Undilated pupil. Topcon TRC-NW400. Color fundus photograph:
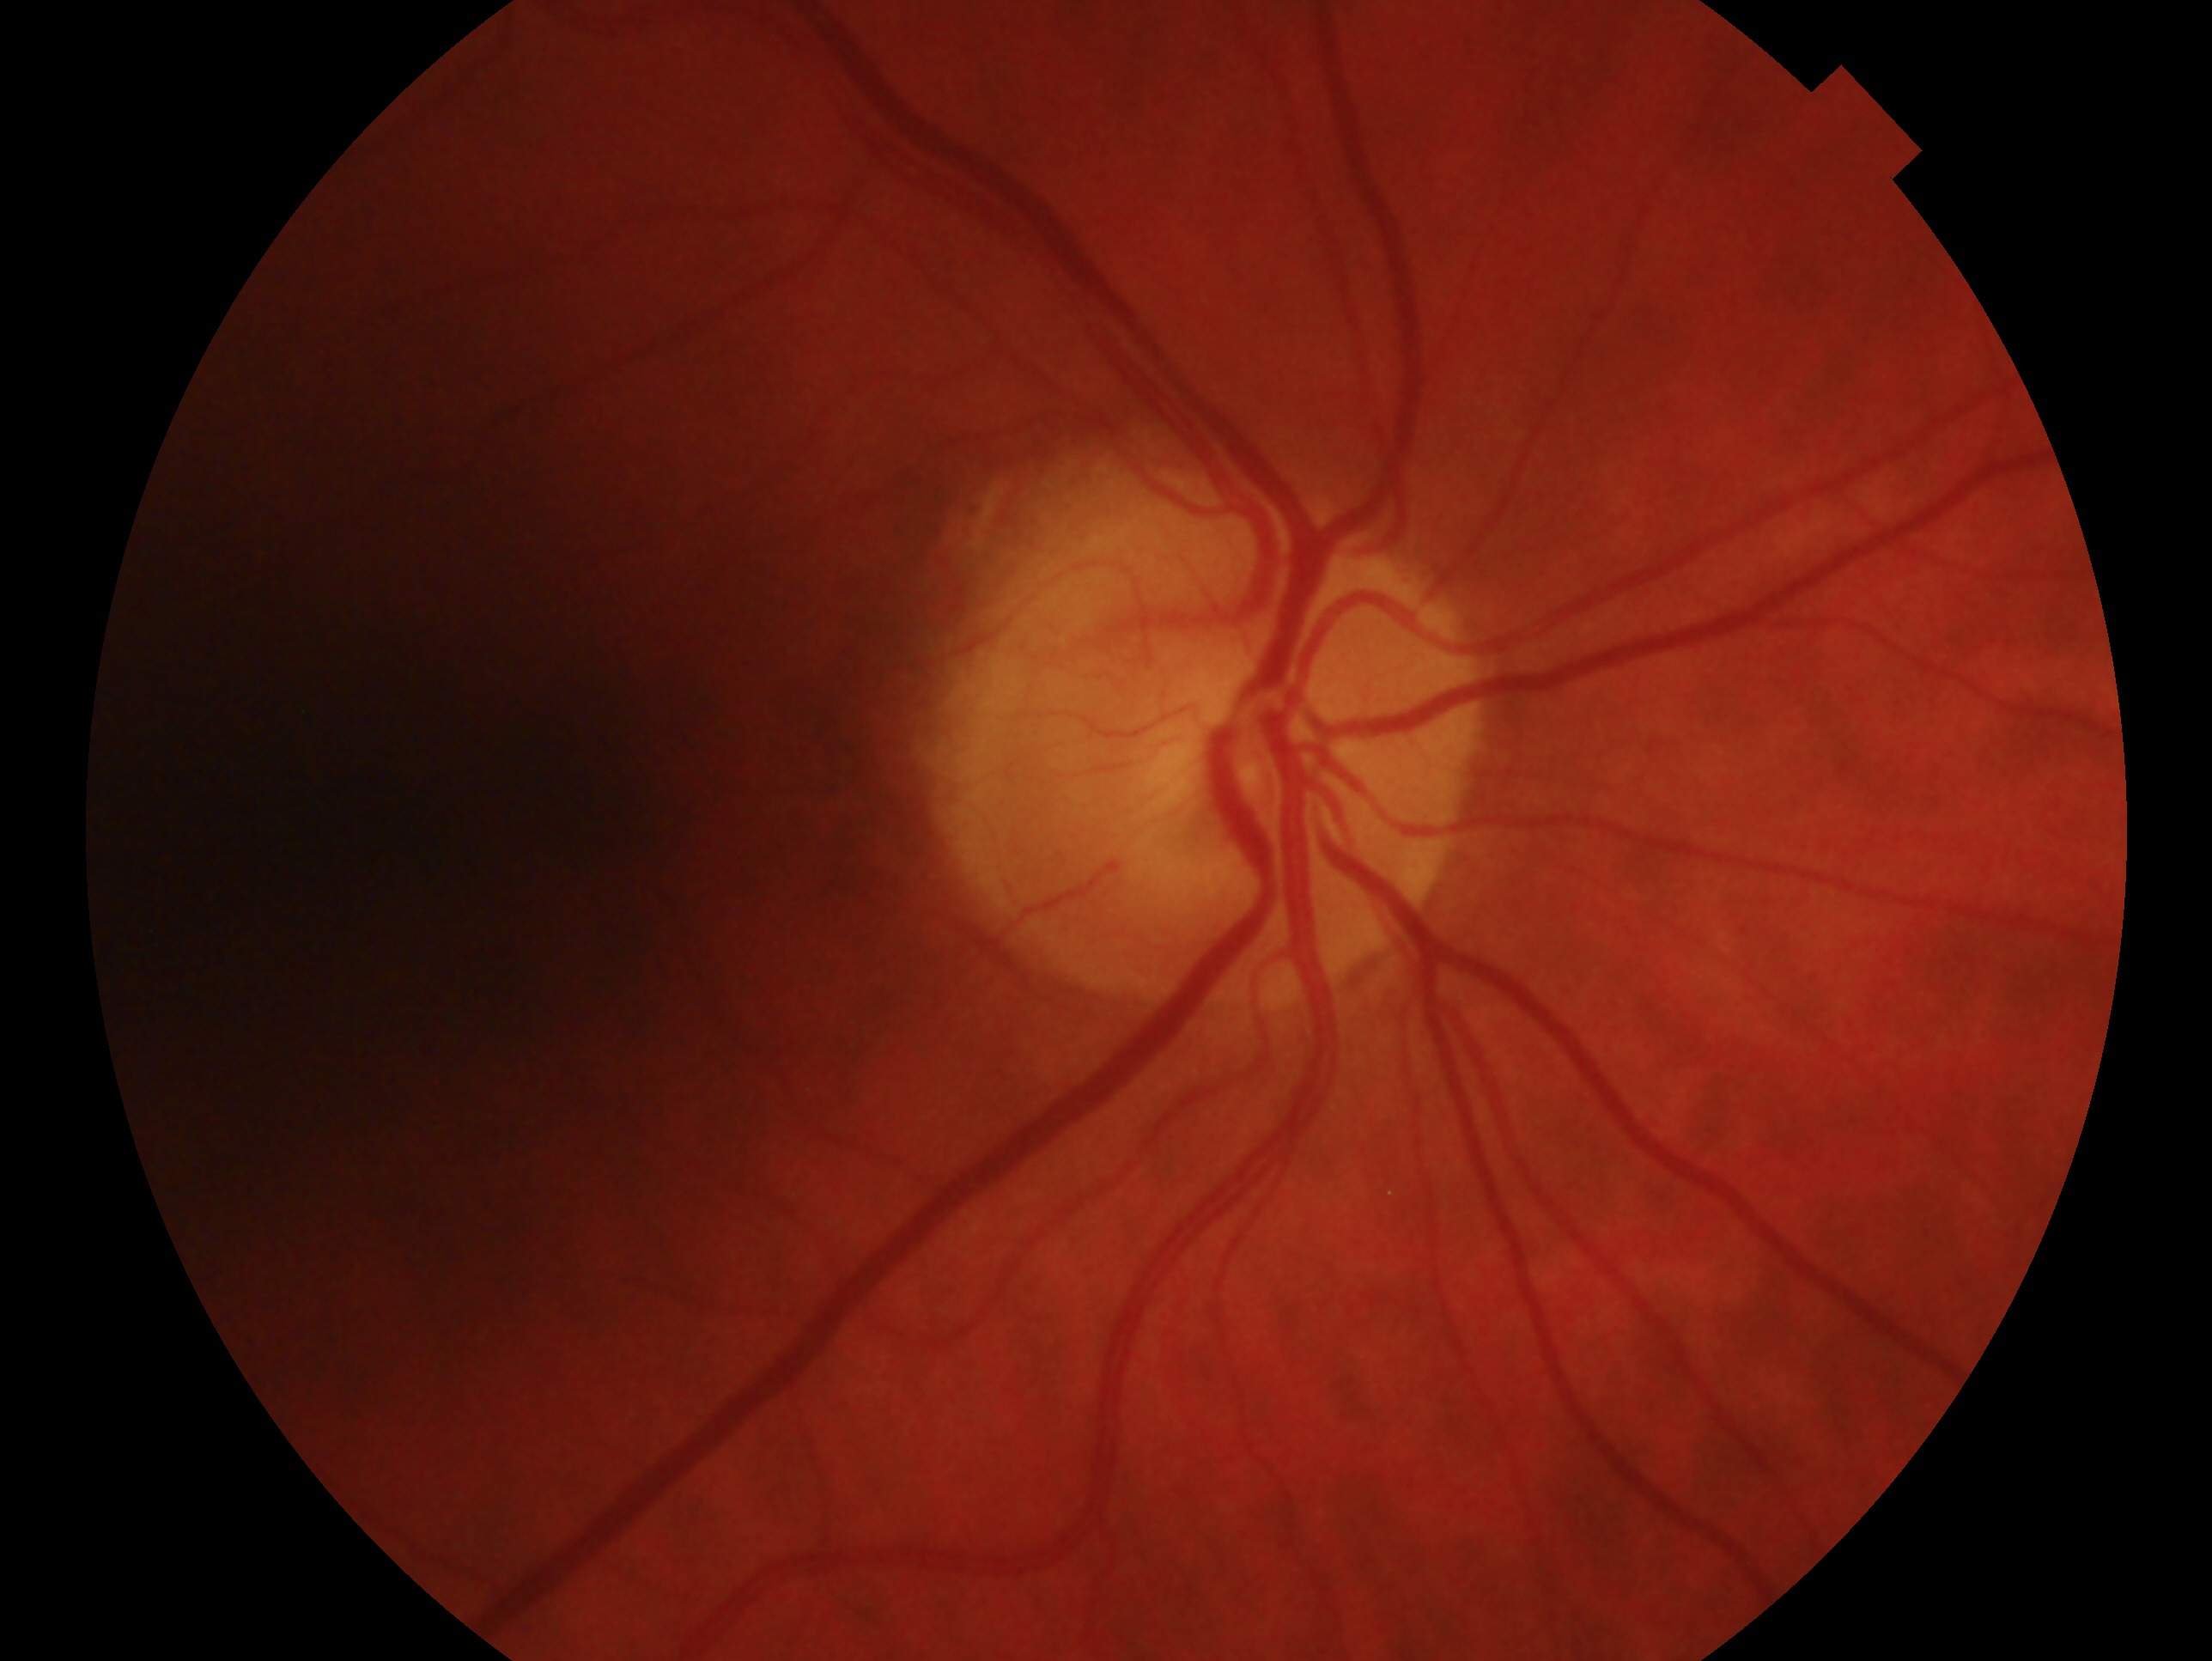 Annotations:
- glaucoma assessment: no glaucomatous findings
- laterality: right eye